Acquired with a Remidio Fundus on Phone (FOP) camera.
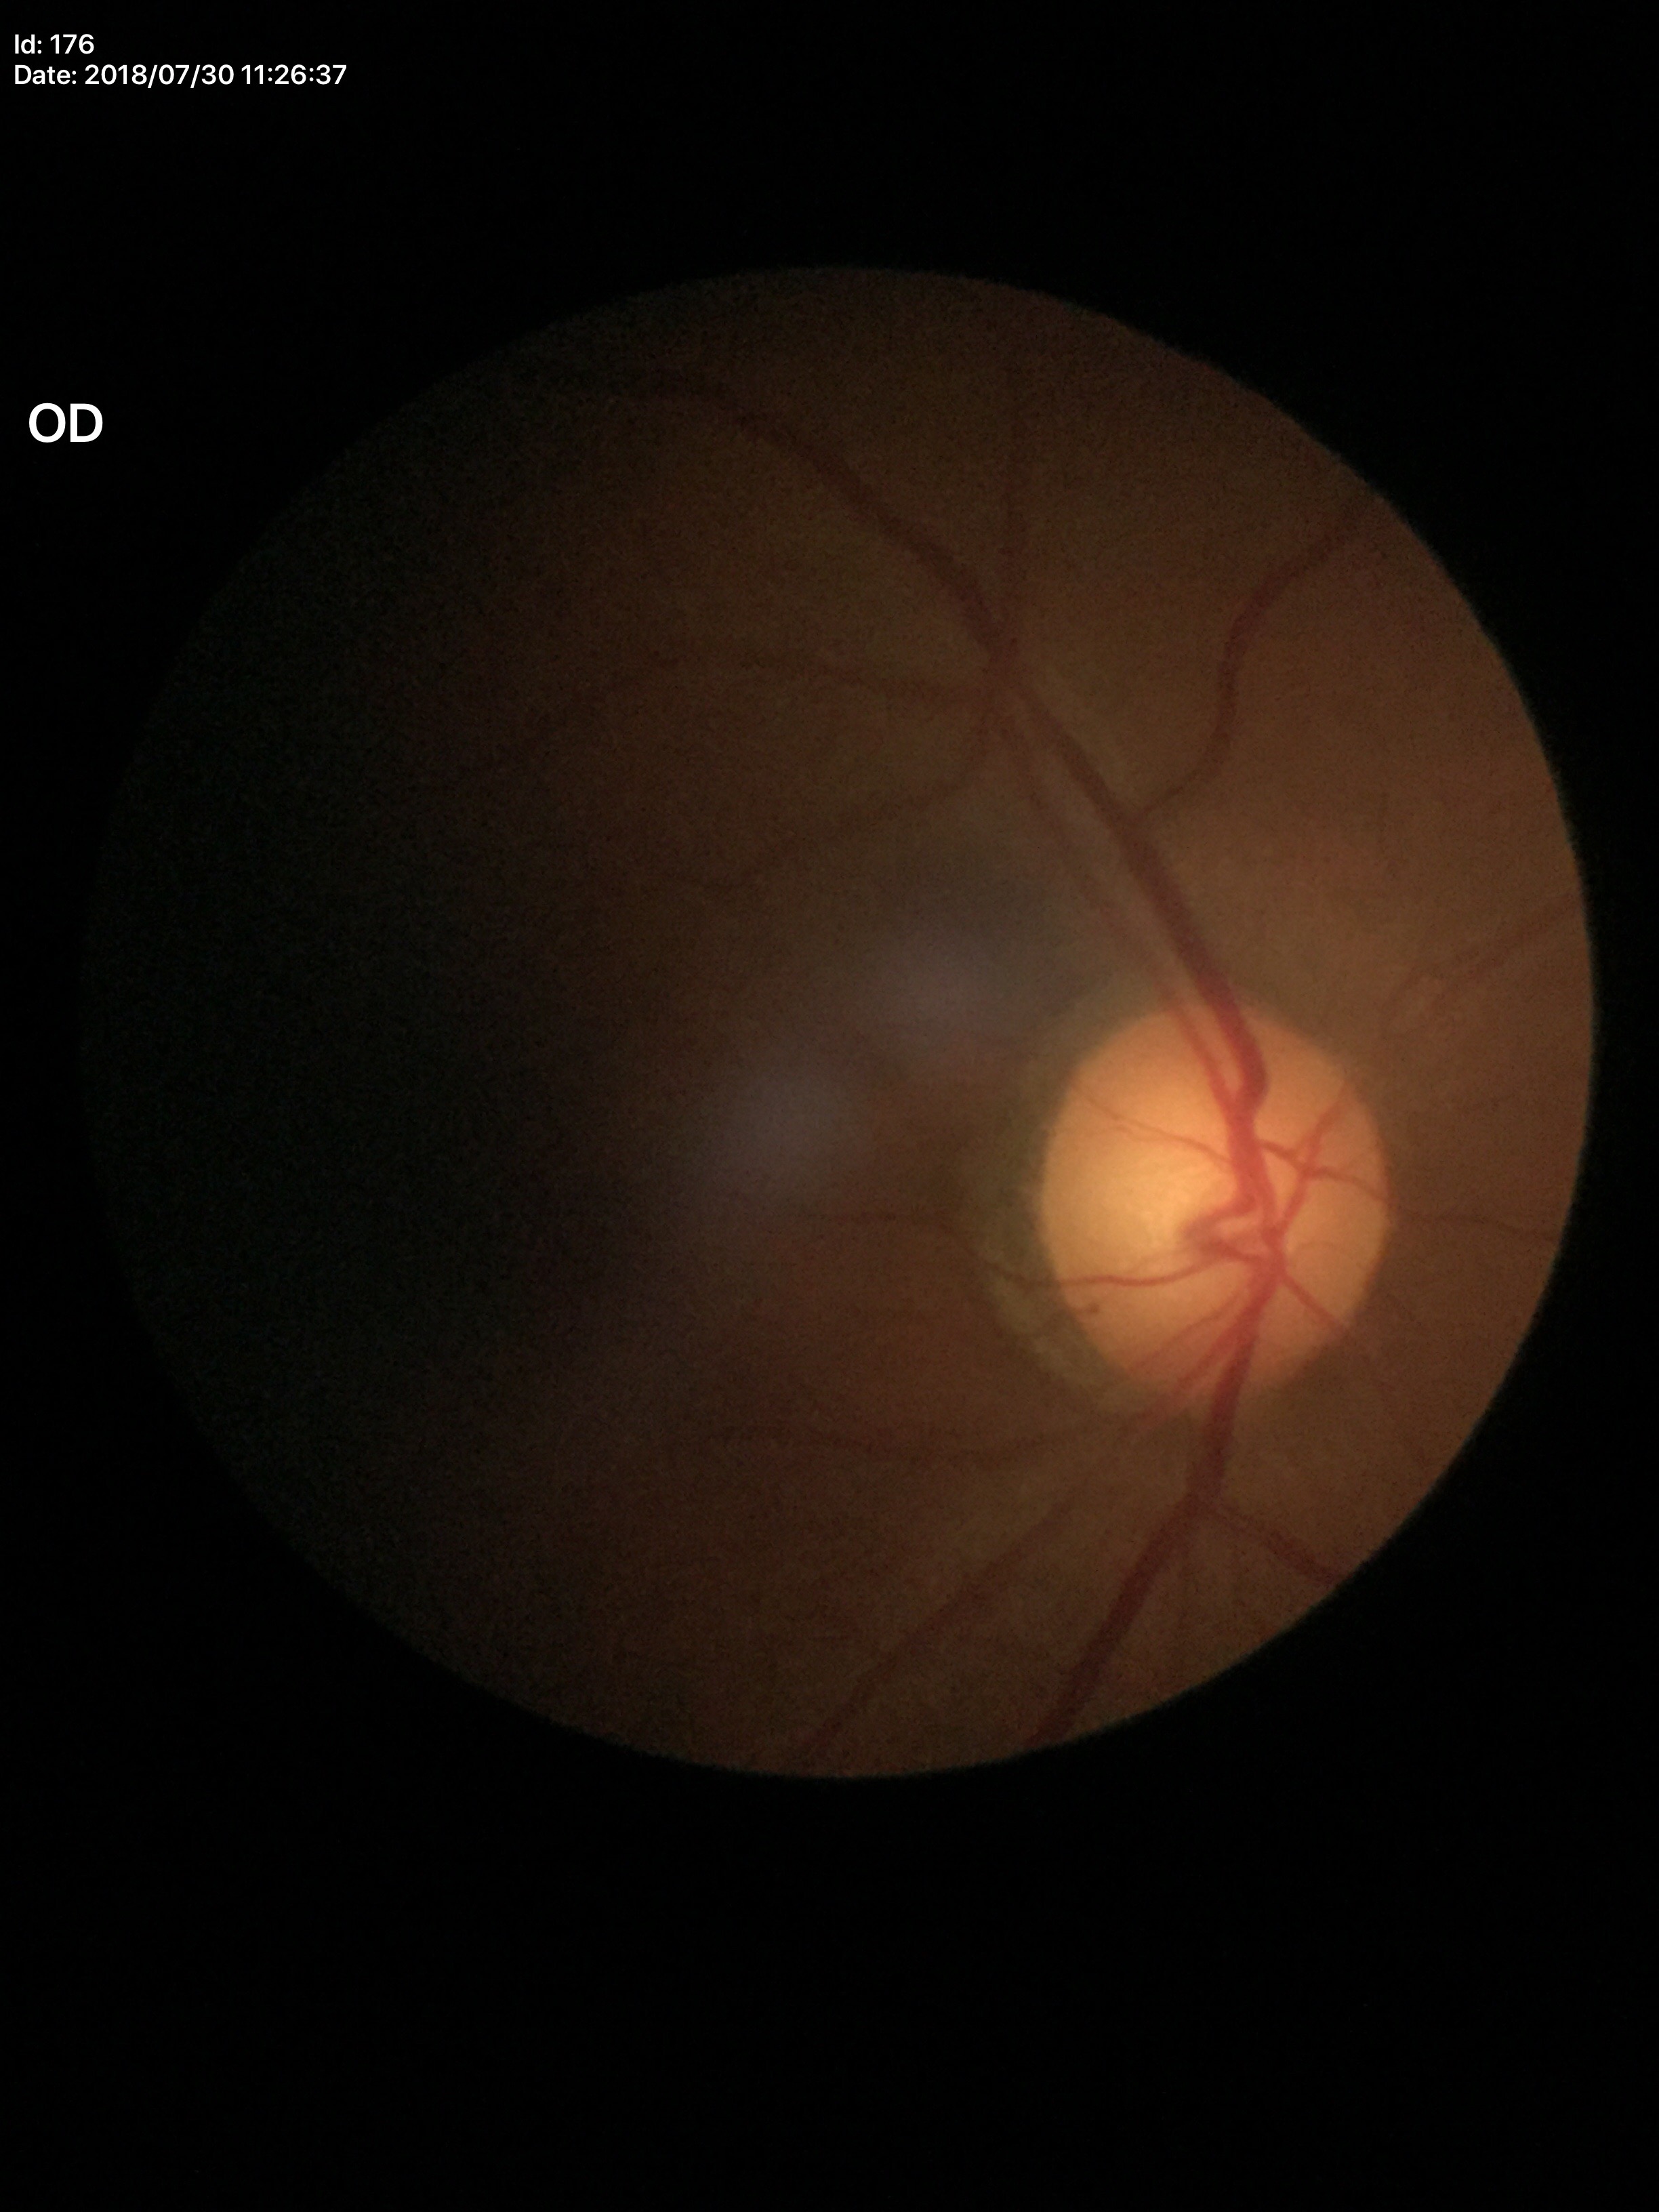 Horizontal cup-to-disc ratio (HCDR): 0.57.
Vertical cup-to-disc ratio (VCDR) of 0.60.
Glaucoma suspect.